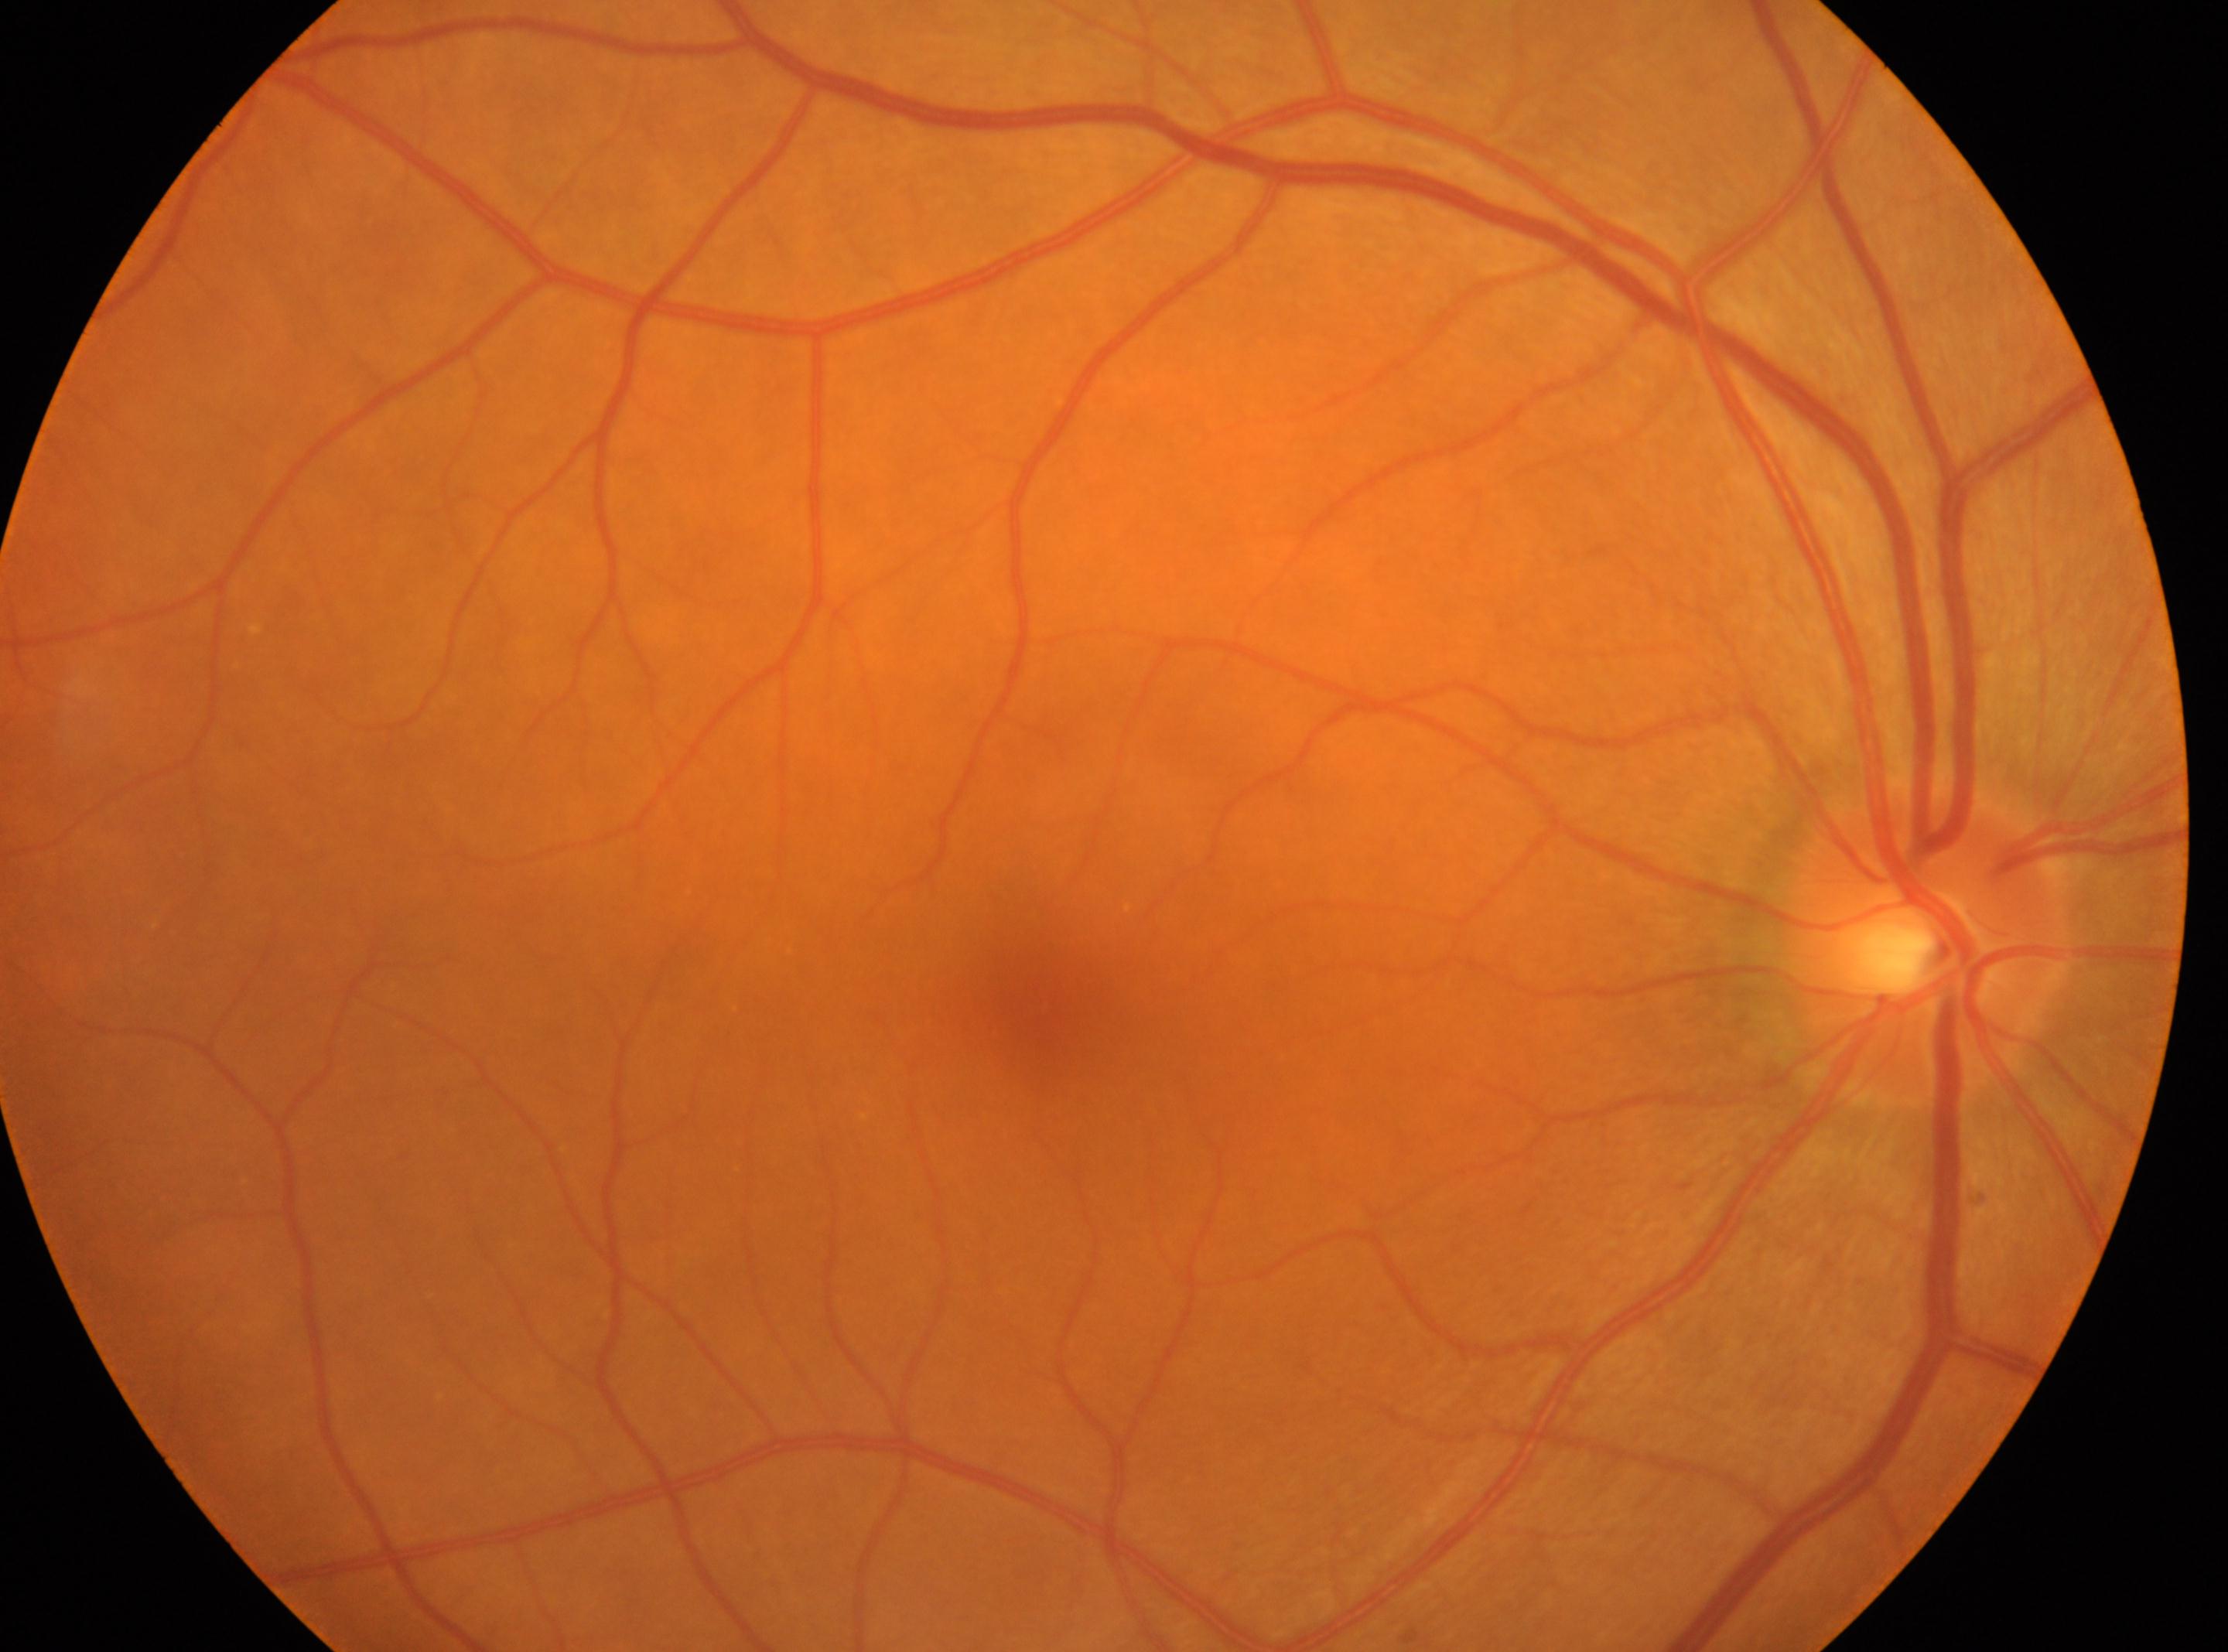 Macular center: [1035, 1002]. The optic disc is at [1927, 945]. Diabetic retinopathy (DR): grade 0 (no apparent retinopathy). Imaged eye: oculus dexter.